45° FOV:
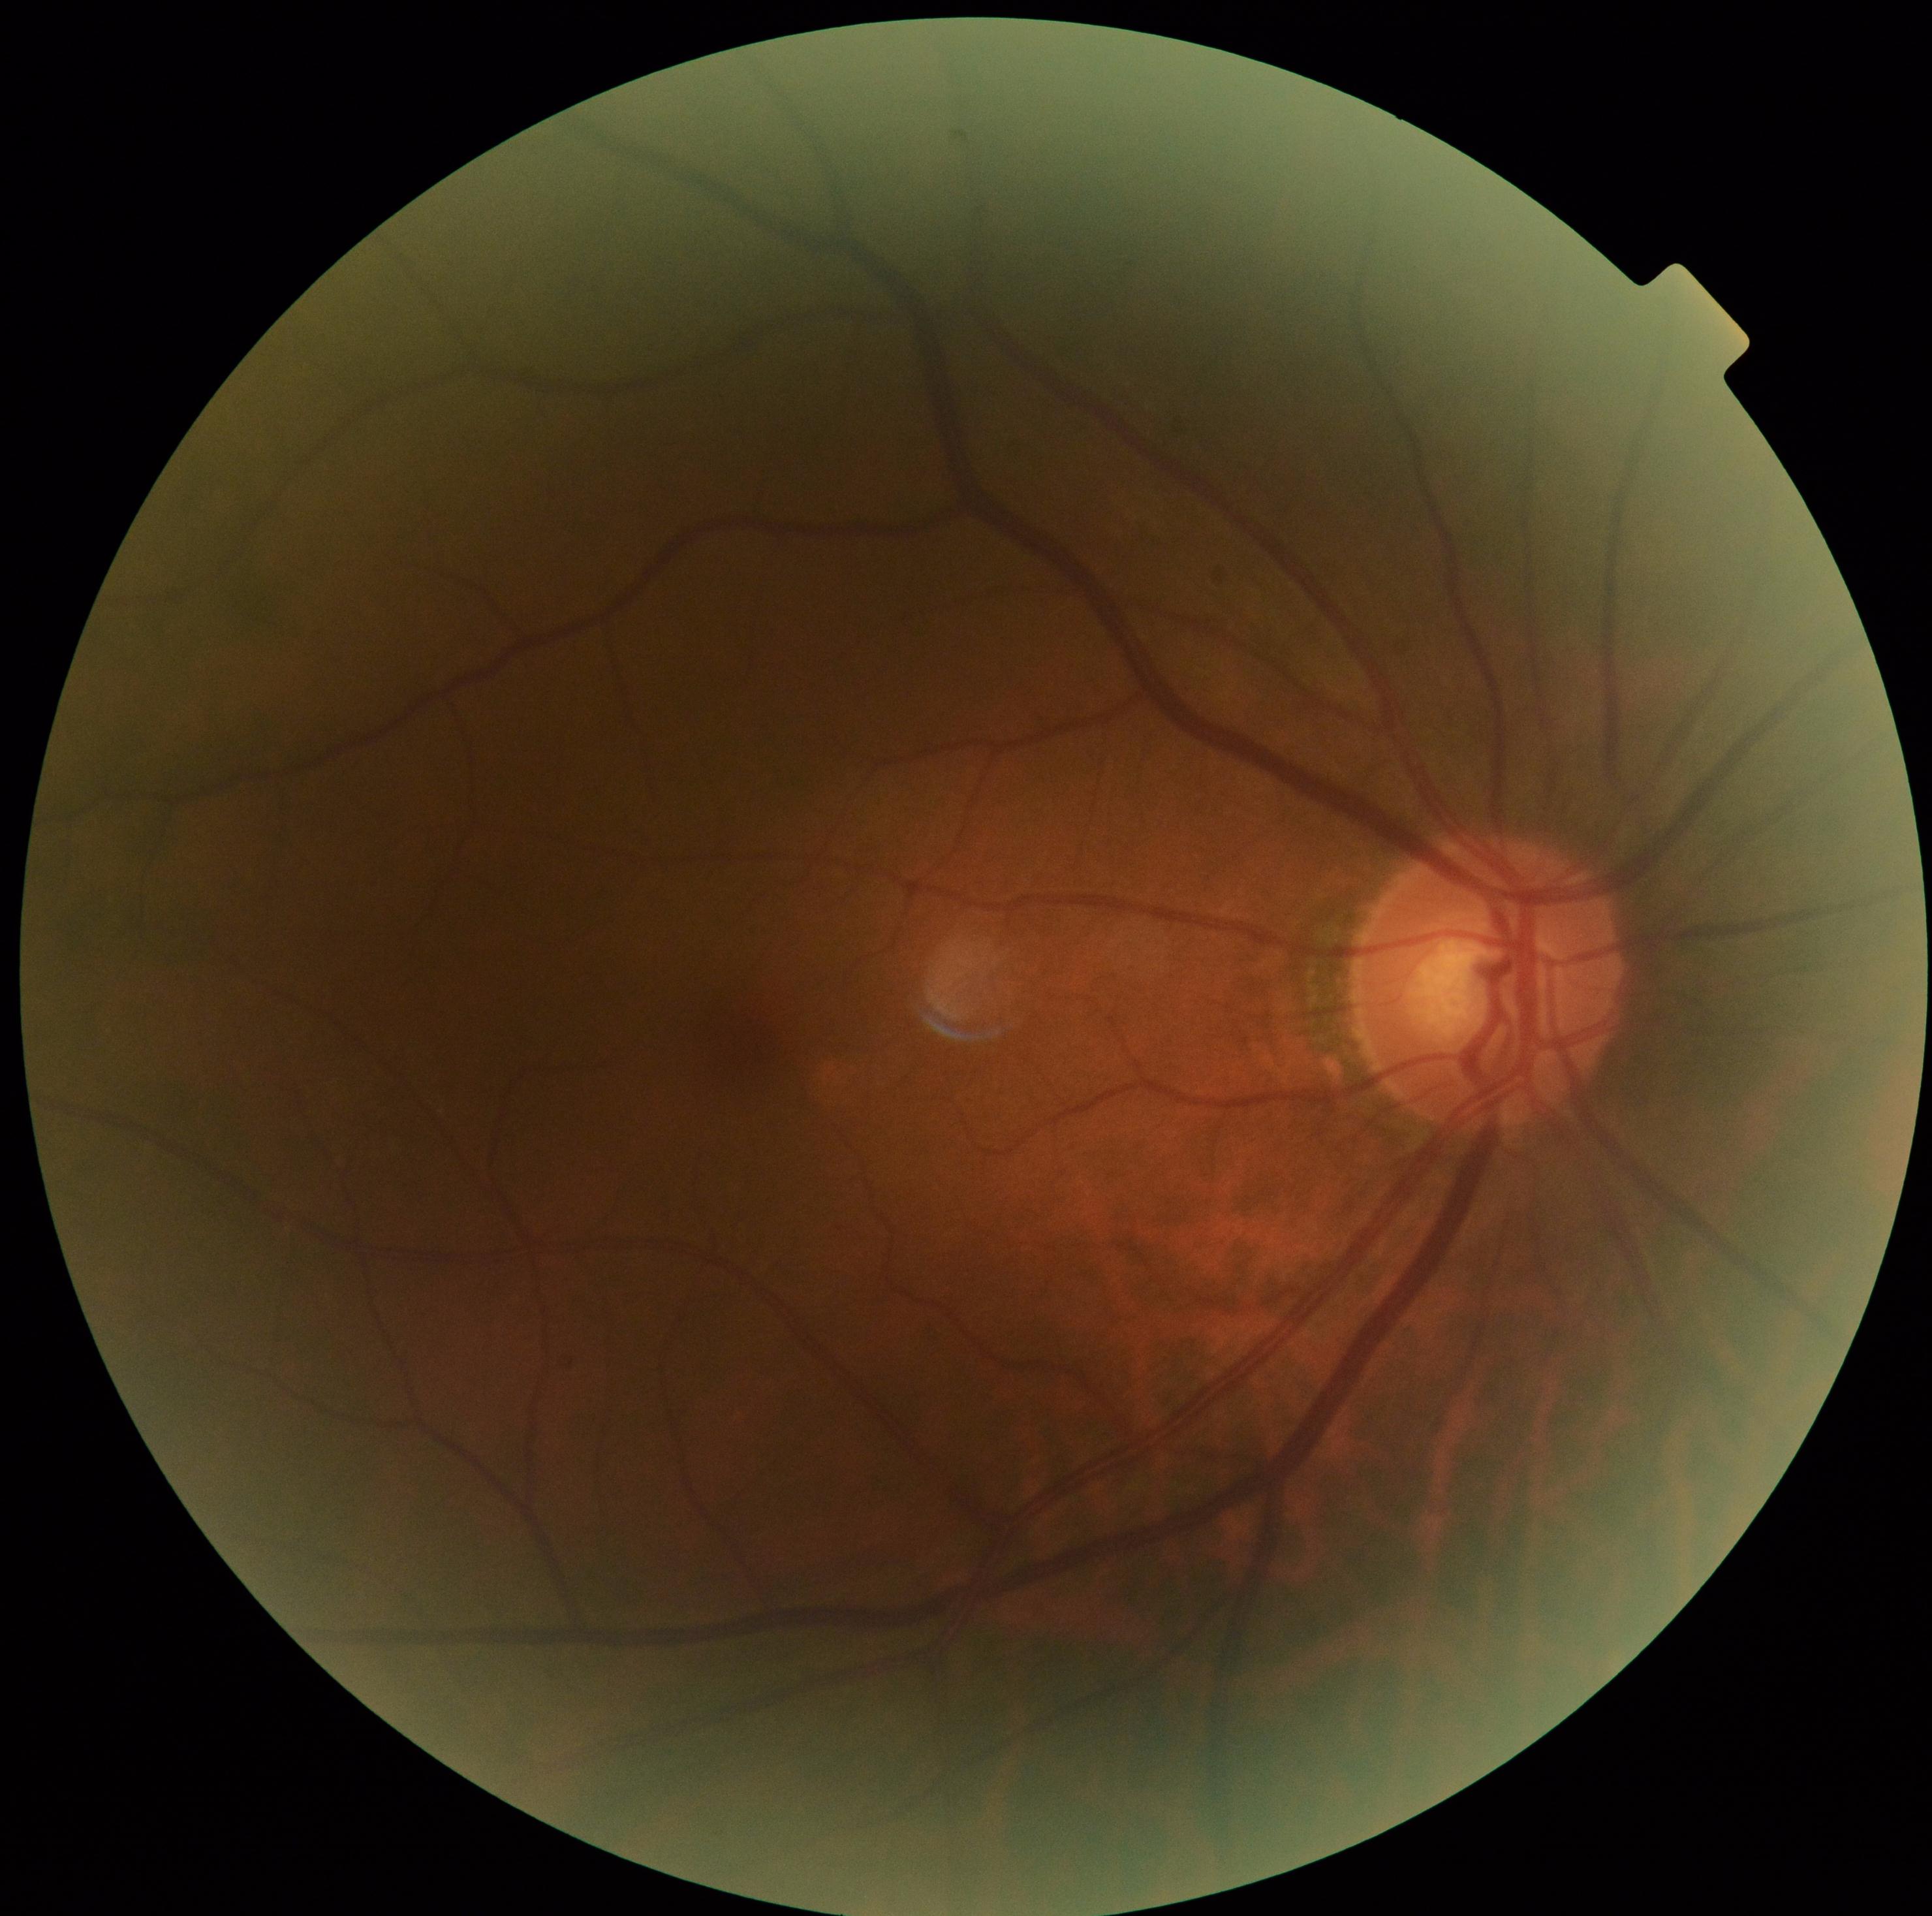 {"dr_impression": "negative for DR", "dr_grade": "grade 0 (no apparent retinopathy)"}